Color fundus image
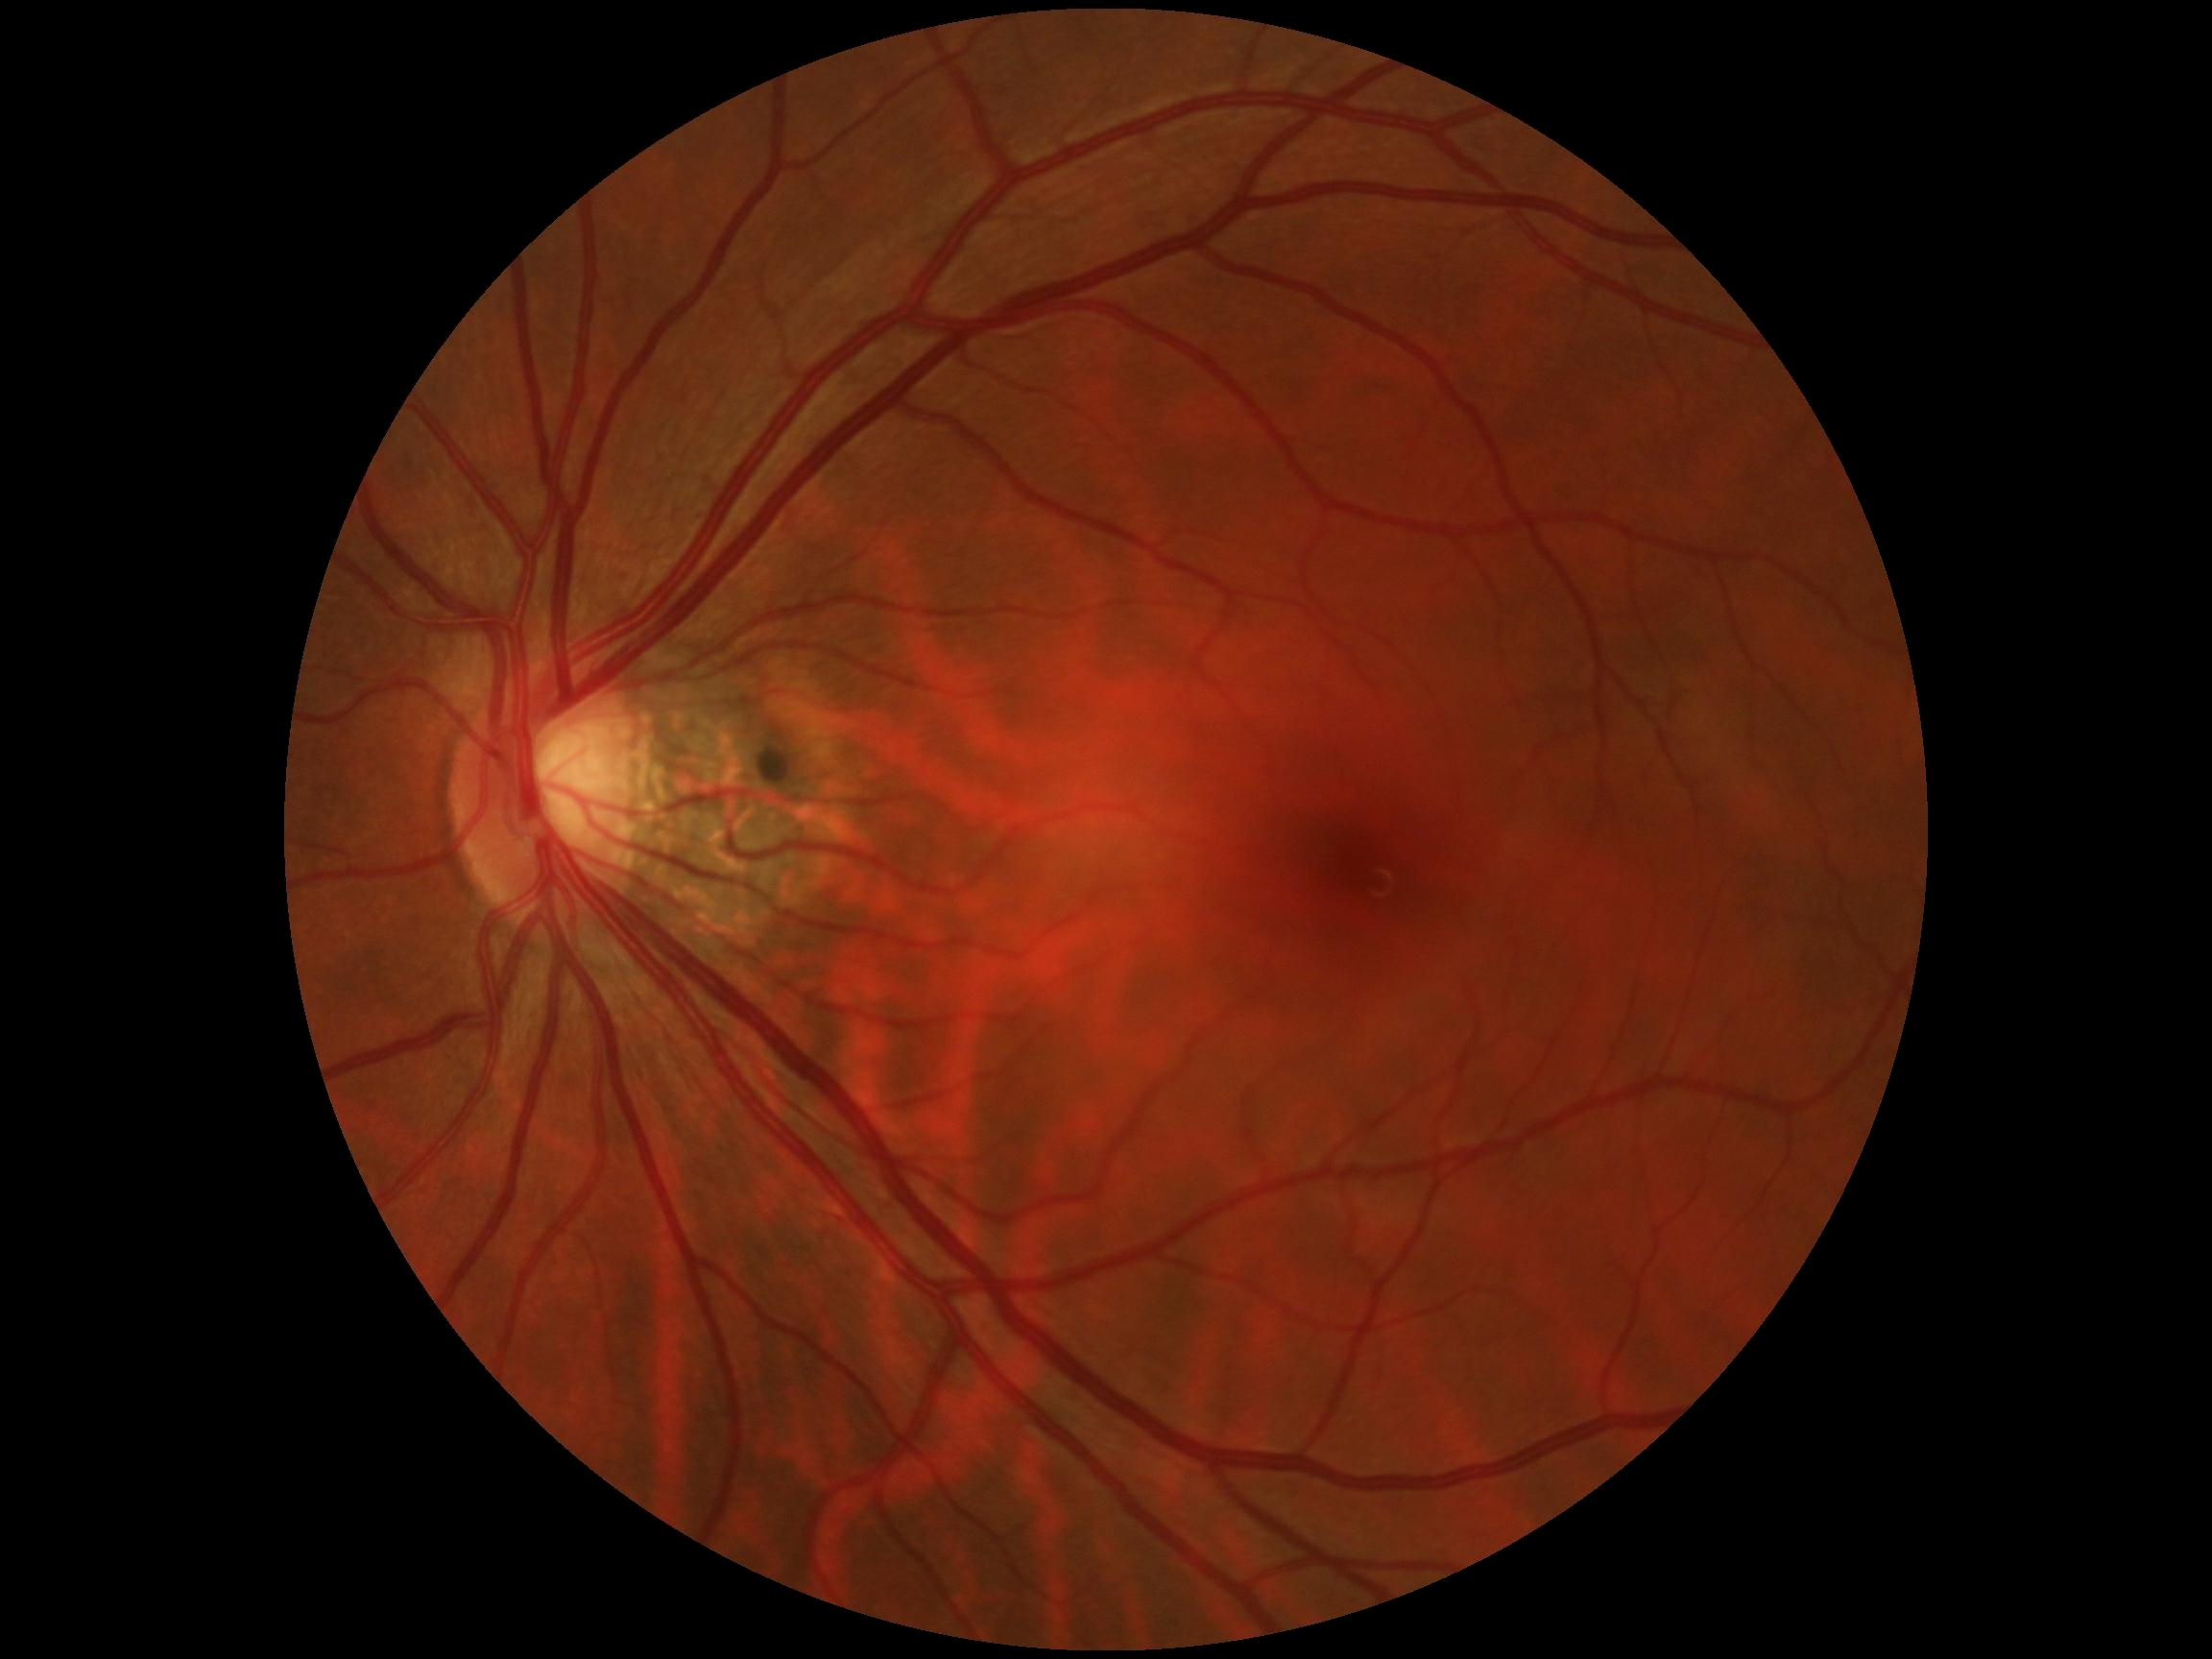

DR impression = no DR findings, diabetic retinopathy = 0.